2361 by 1568 pixels · color fundus photograph · captured on a Kowa VX-10α fundus camera · macula at the center of the field.
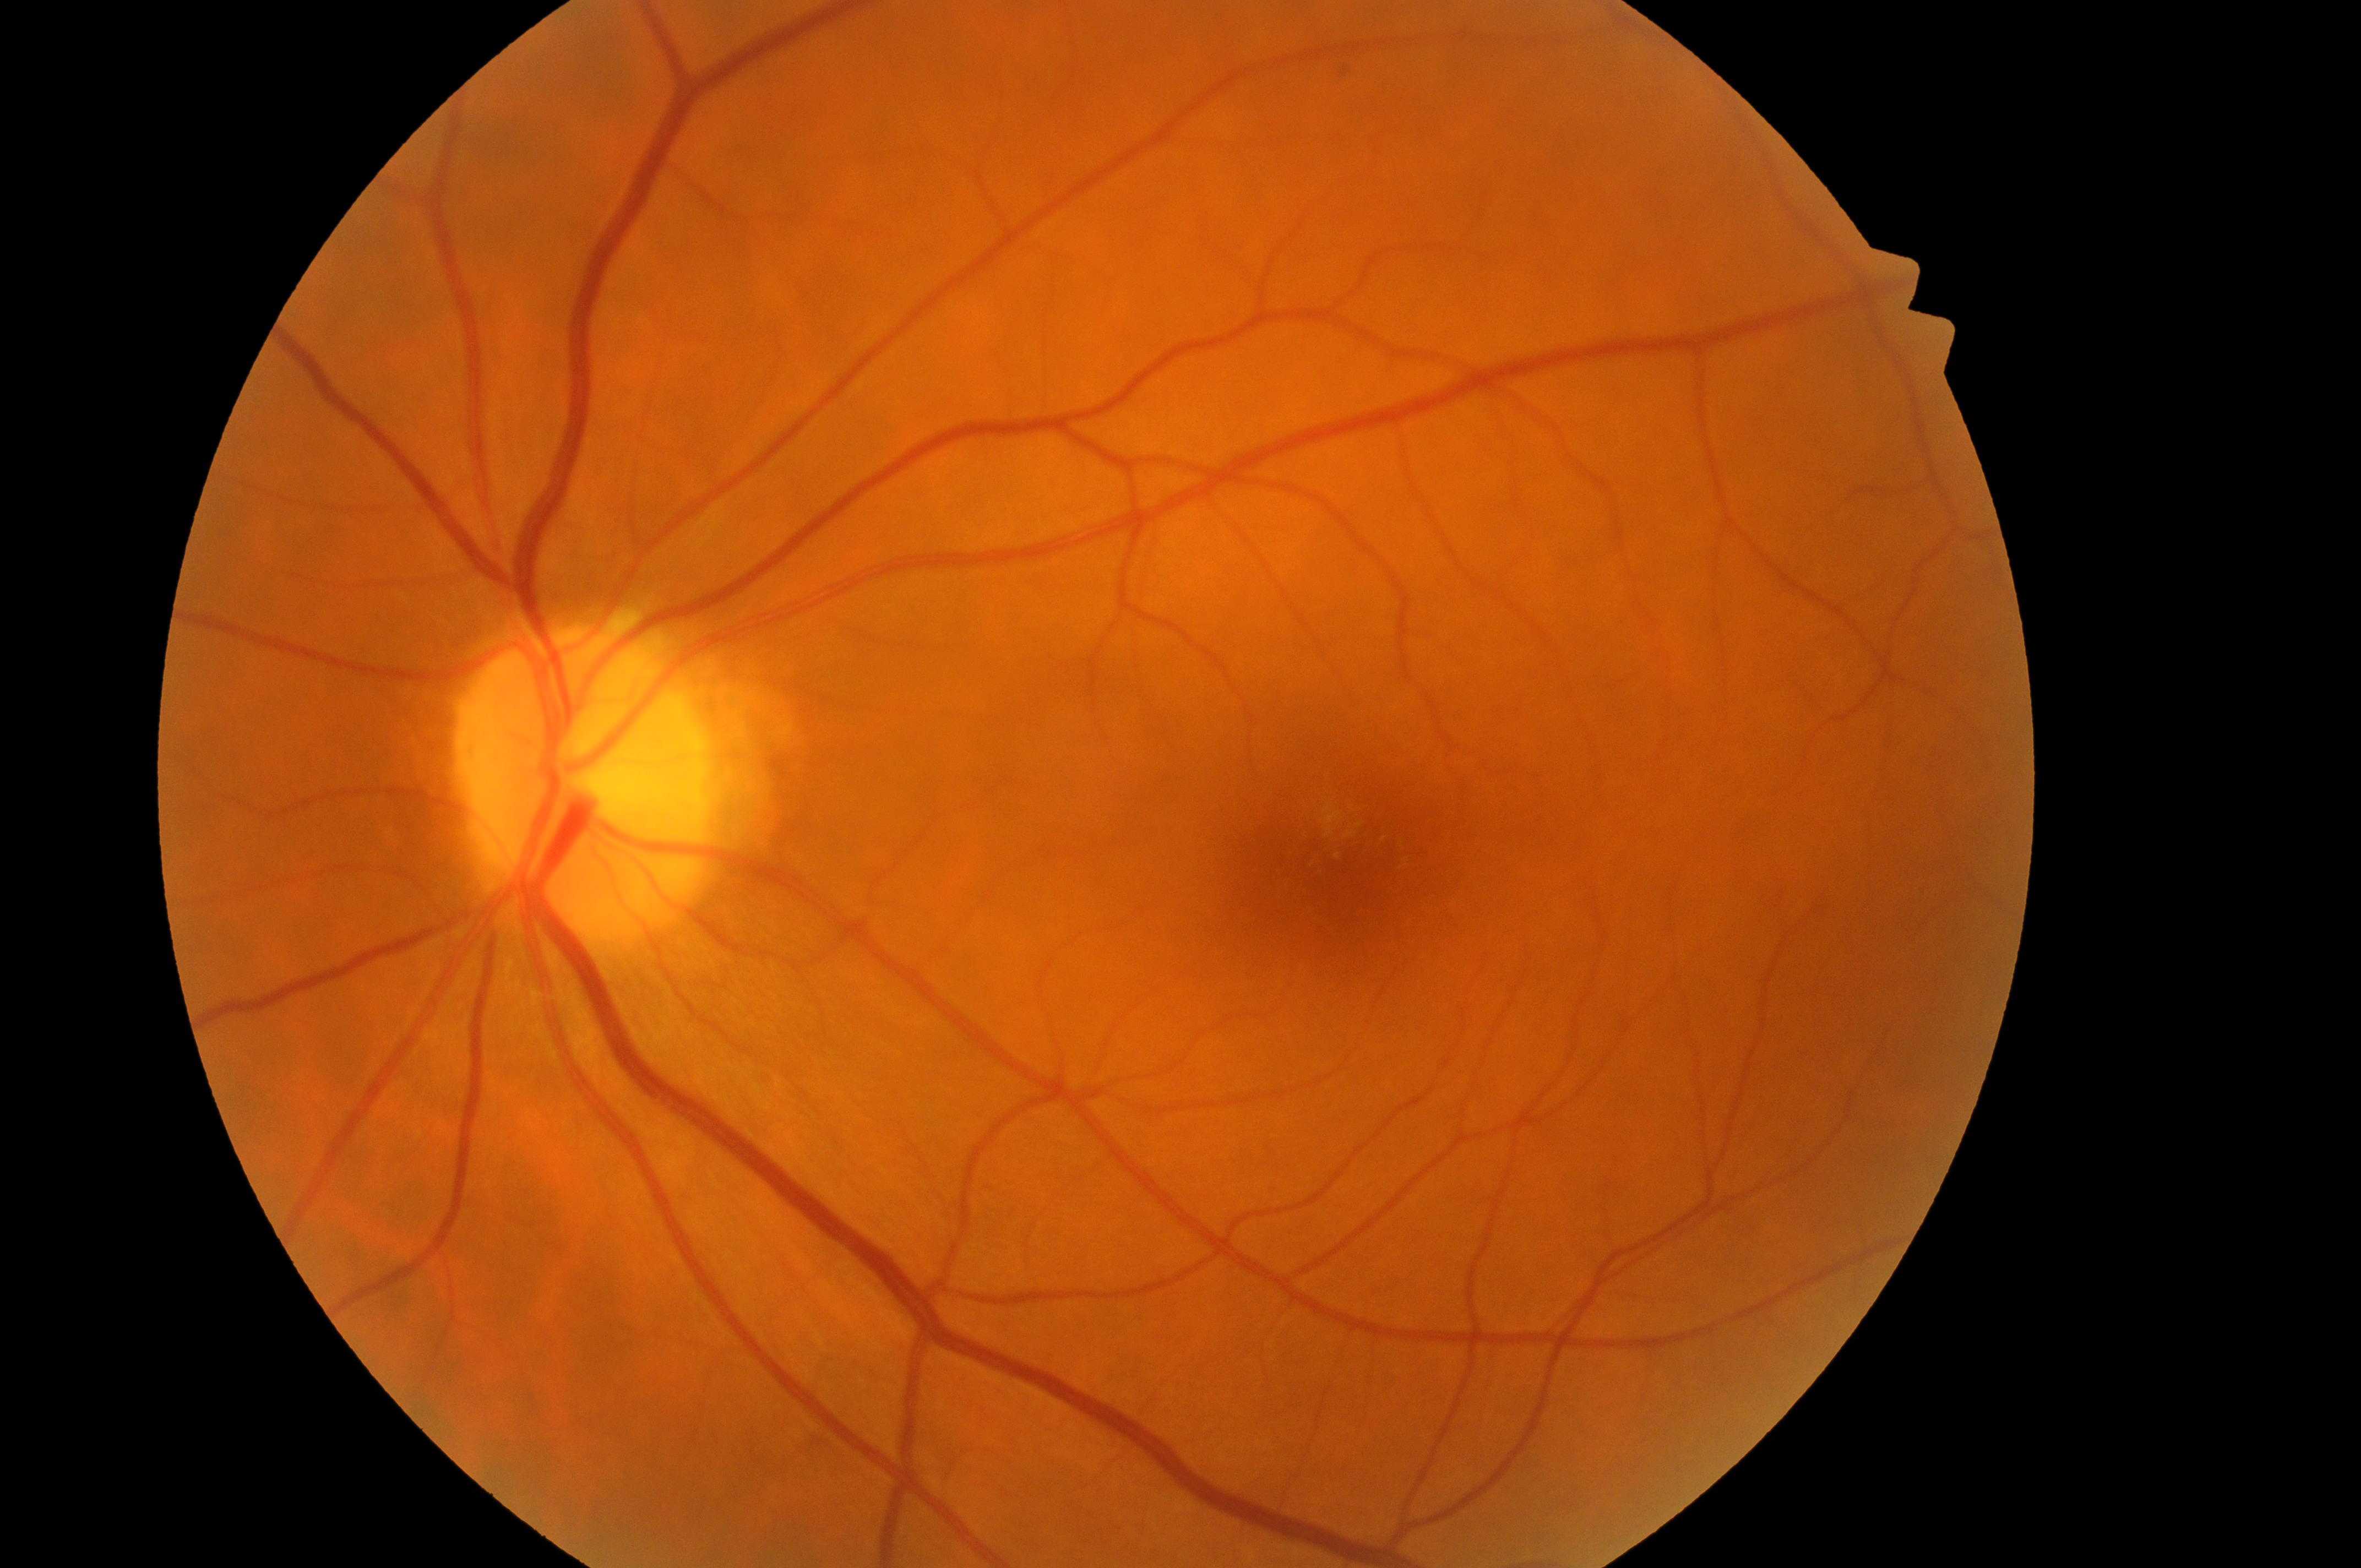   optic_disc: 581, 792
  dme_grade: high risk (grade 2)
  dr_category: non-proliferative diabetic retinopathy
  fovea: 1351, 872
  eye: the left eye
  dr_grade: 2 (moderate NPDR)